1659 x 2212 pixels, color fundus image, captured on a Remidio Fundus on Phone: 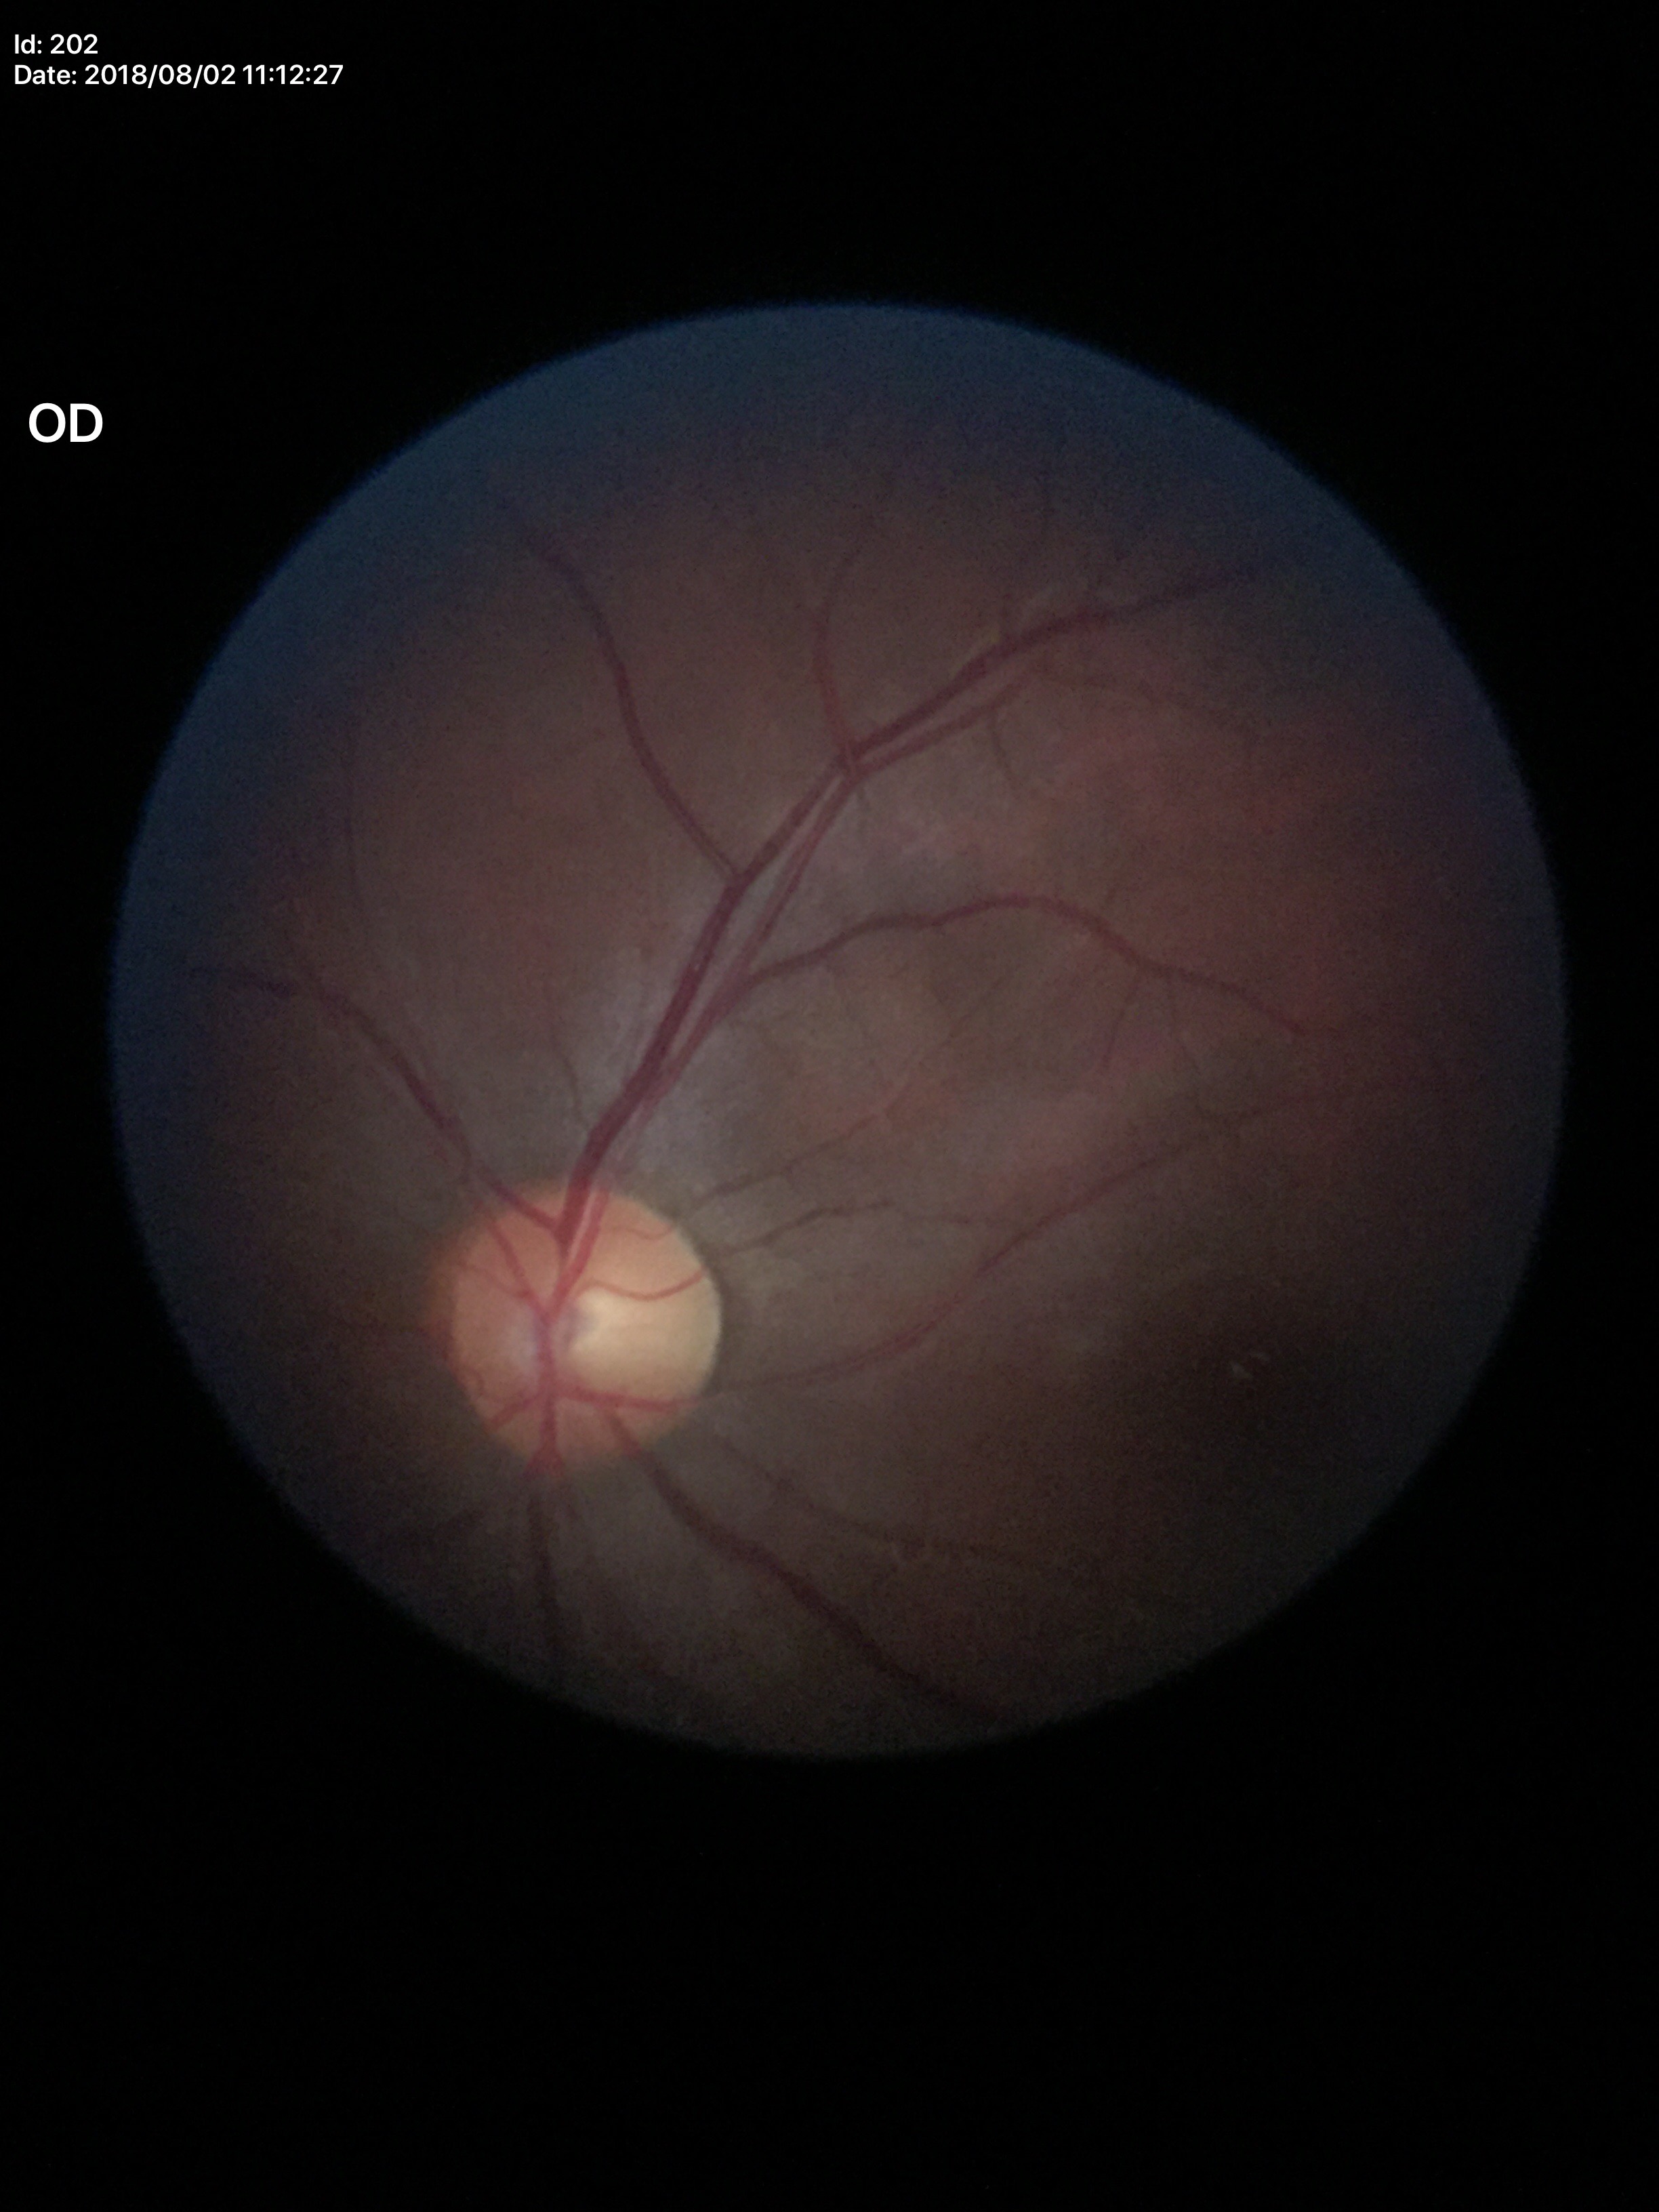

No signs of glaucoma (5/5 ophthalmologists in agreement).
Area CDR (ACDR) of 0.22.
Vertical C/D ratio (VCDR) is 0.47.